Acquired with a NIDEK AFC-230. 848x848. Graded on the modified Davis scale:
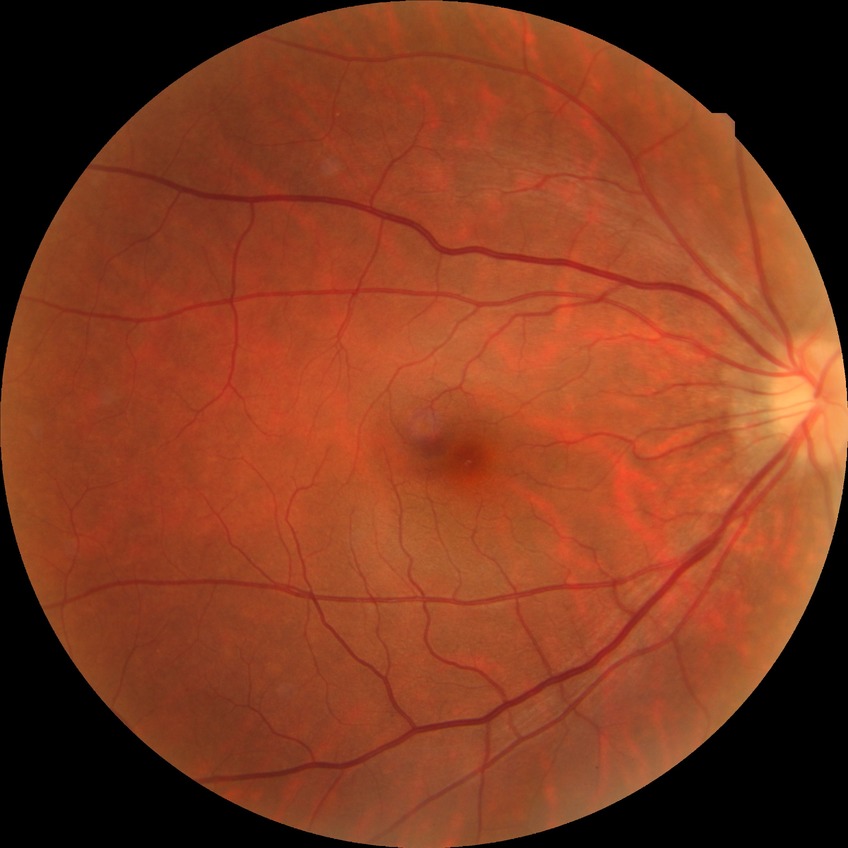

Diabetic retinopathy (DR): no diabetic retinopathy (NDR).